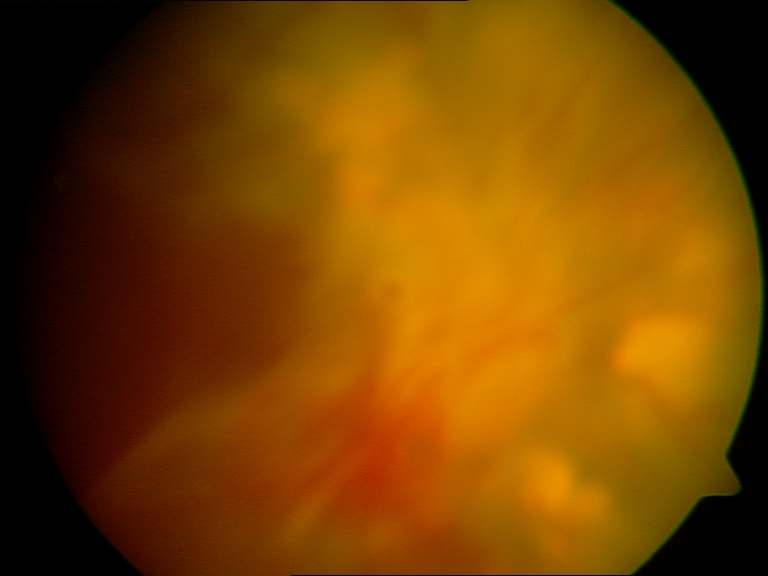 Image quality: poor, substantial obscuration of retinal landmarks. Proliferative diabetic retinopathy: features suspicious.